Ultra-widefield (UWF) fundus image:
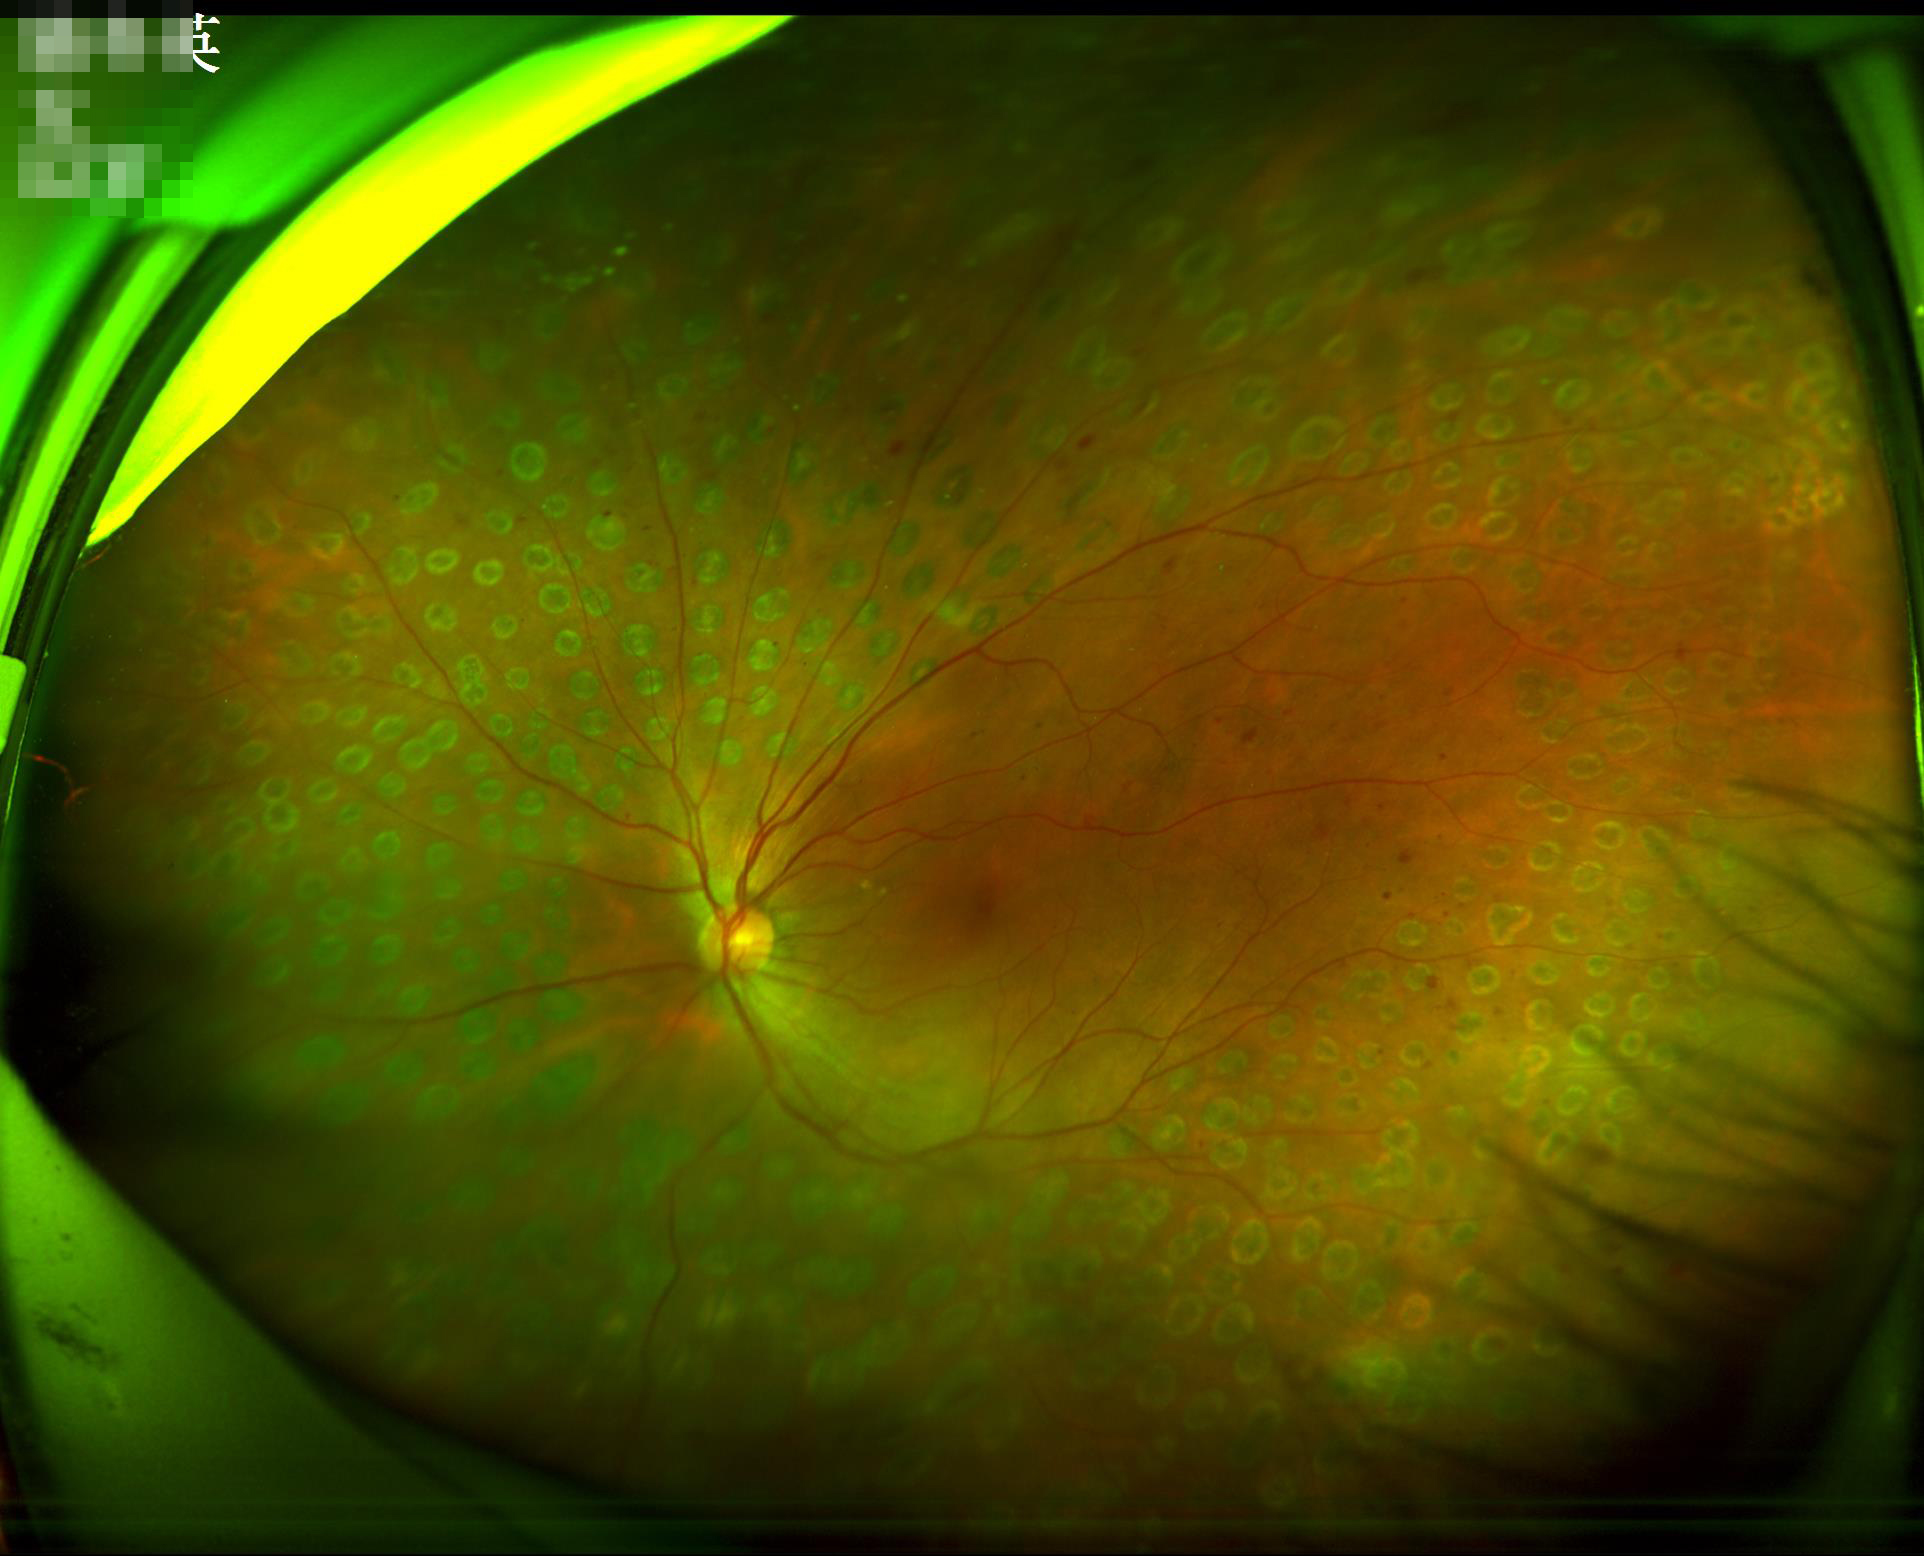

Image quality assessment: overall: adequate | illumination: poor | focus: out of focus.